No pharmacologic dilation: 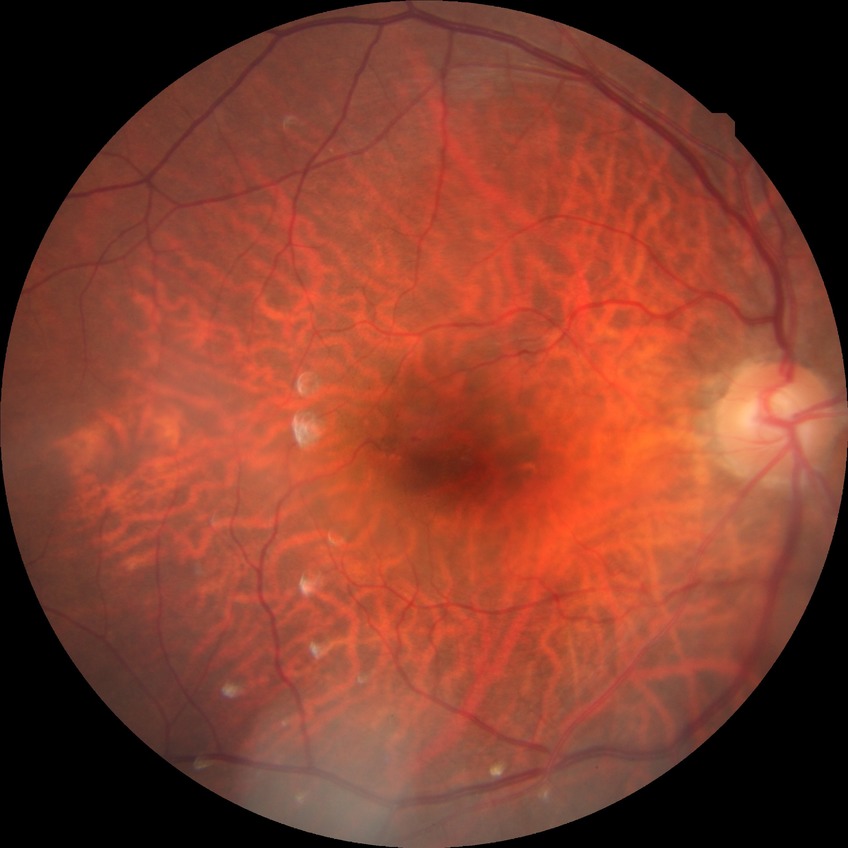 Davis grading is simple diabetic retinopathy.